Diabetic retinopathy graded by the modified Davis classification
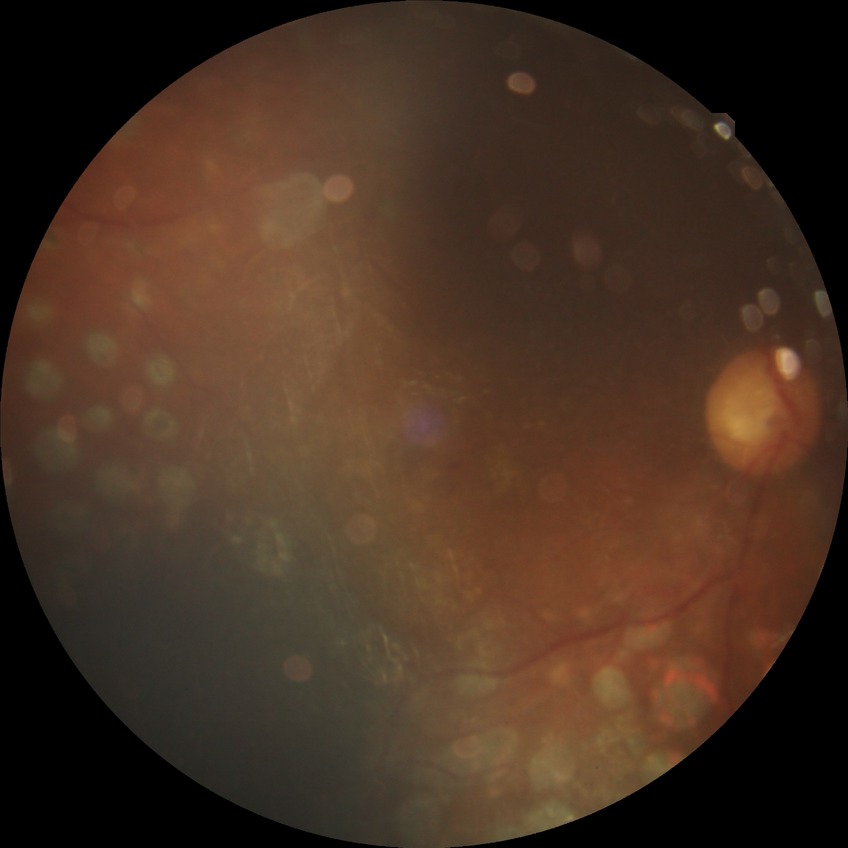 diabetic retinopathy (DR) = PDR (proliferative diabetic retinopathy)